45° FOV — 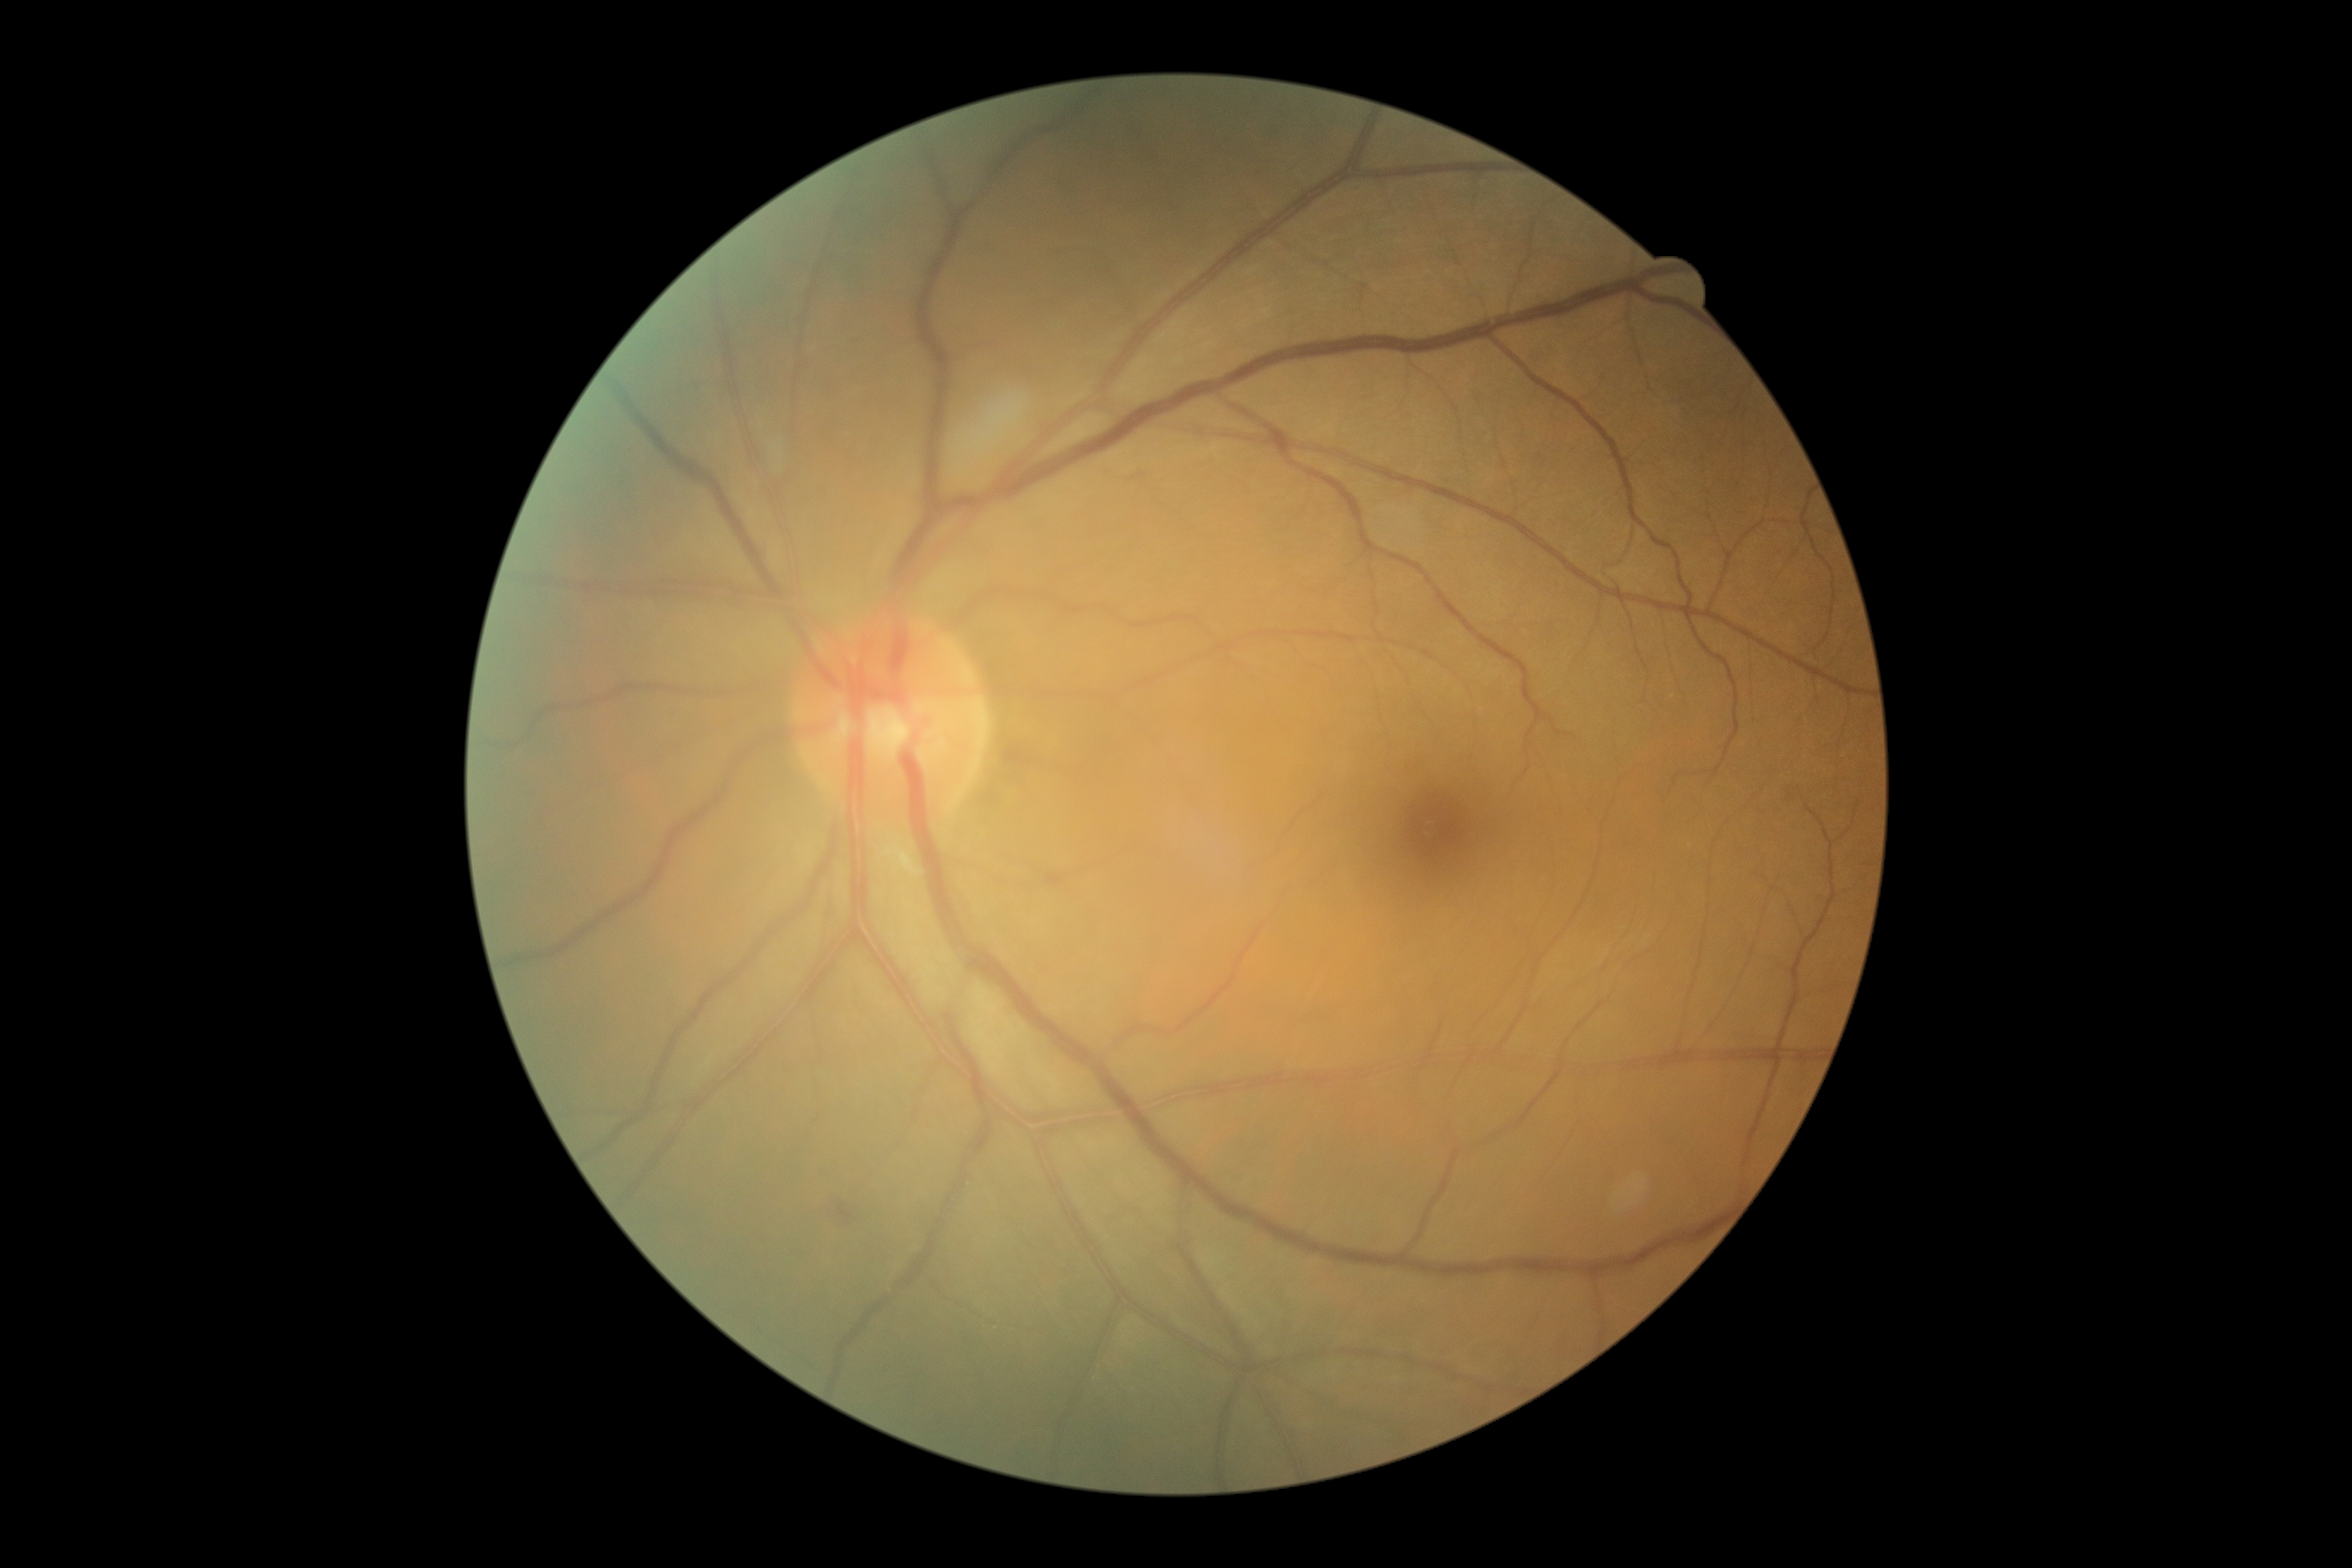

dr_grade: grade 2 (moderate NPDR)
dr_category: non-proliferative diabetic retinopathy